Acquired with a Nidek AFC-330. Centered on the optic disc. Fundus photo: 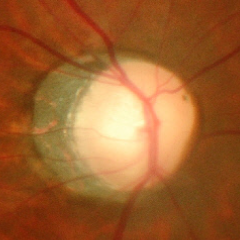 Findings consistent with advanced-stage glaucoma.